Wide-field fundus photograph from neonatal ROP screening; image size 1440x1080; Natus RetCam Envision, 130° FOV
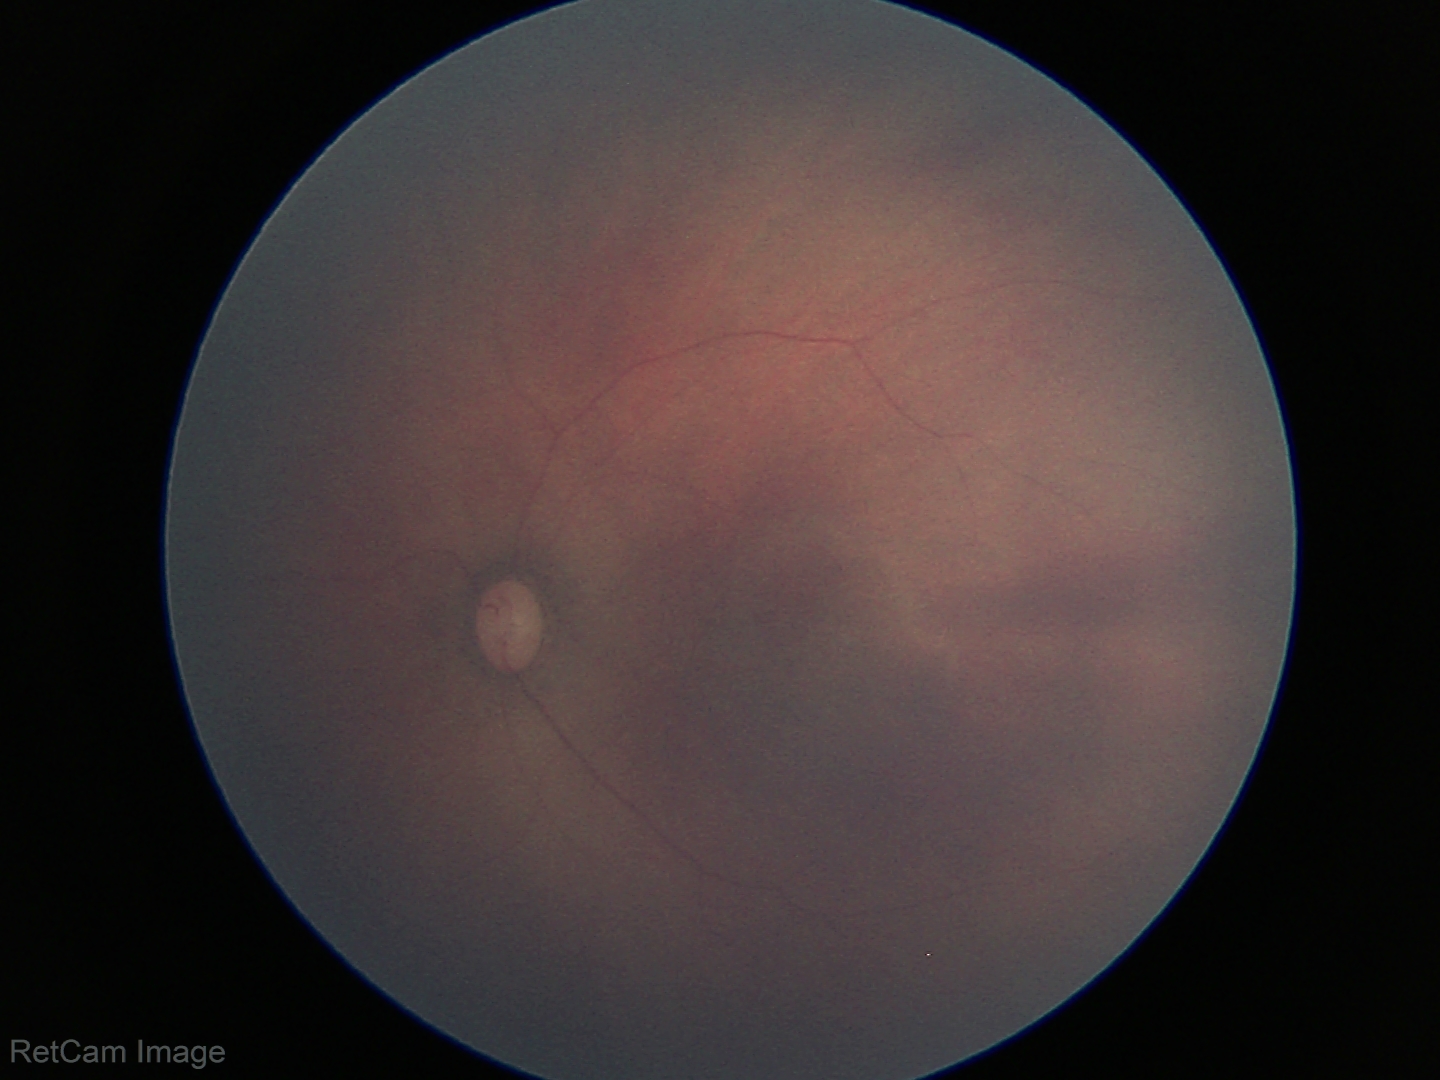

Assessment: physiological finding.